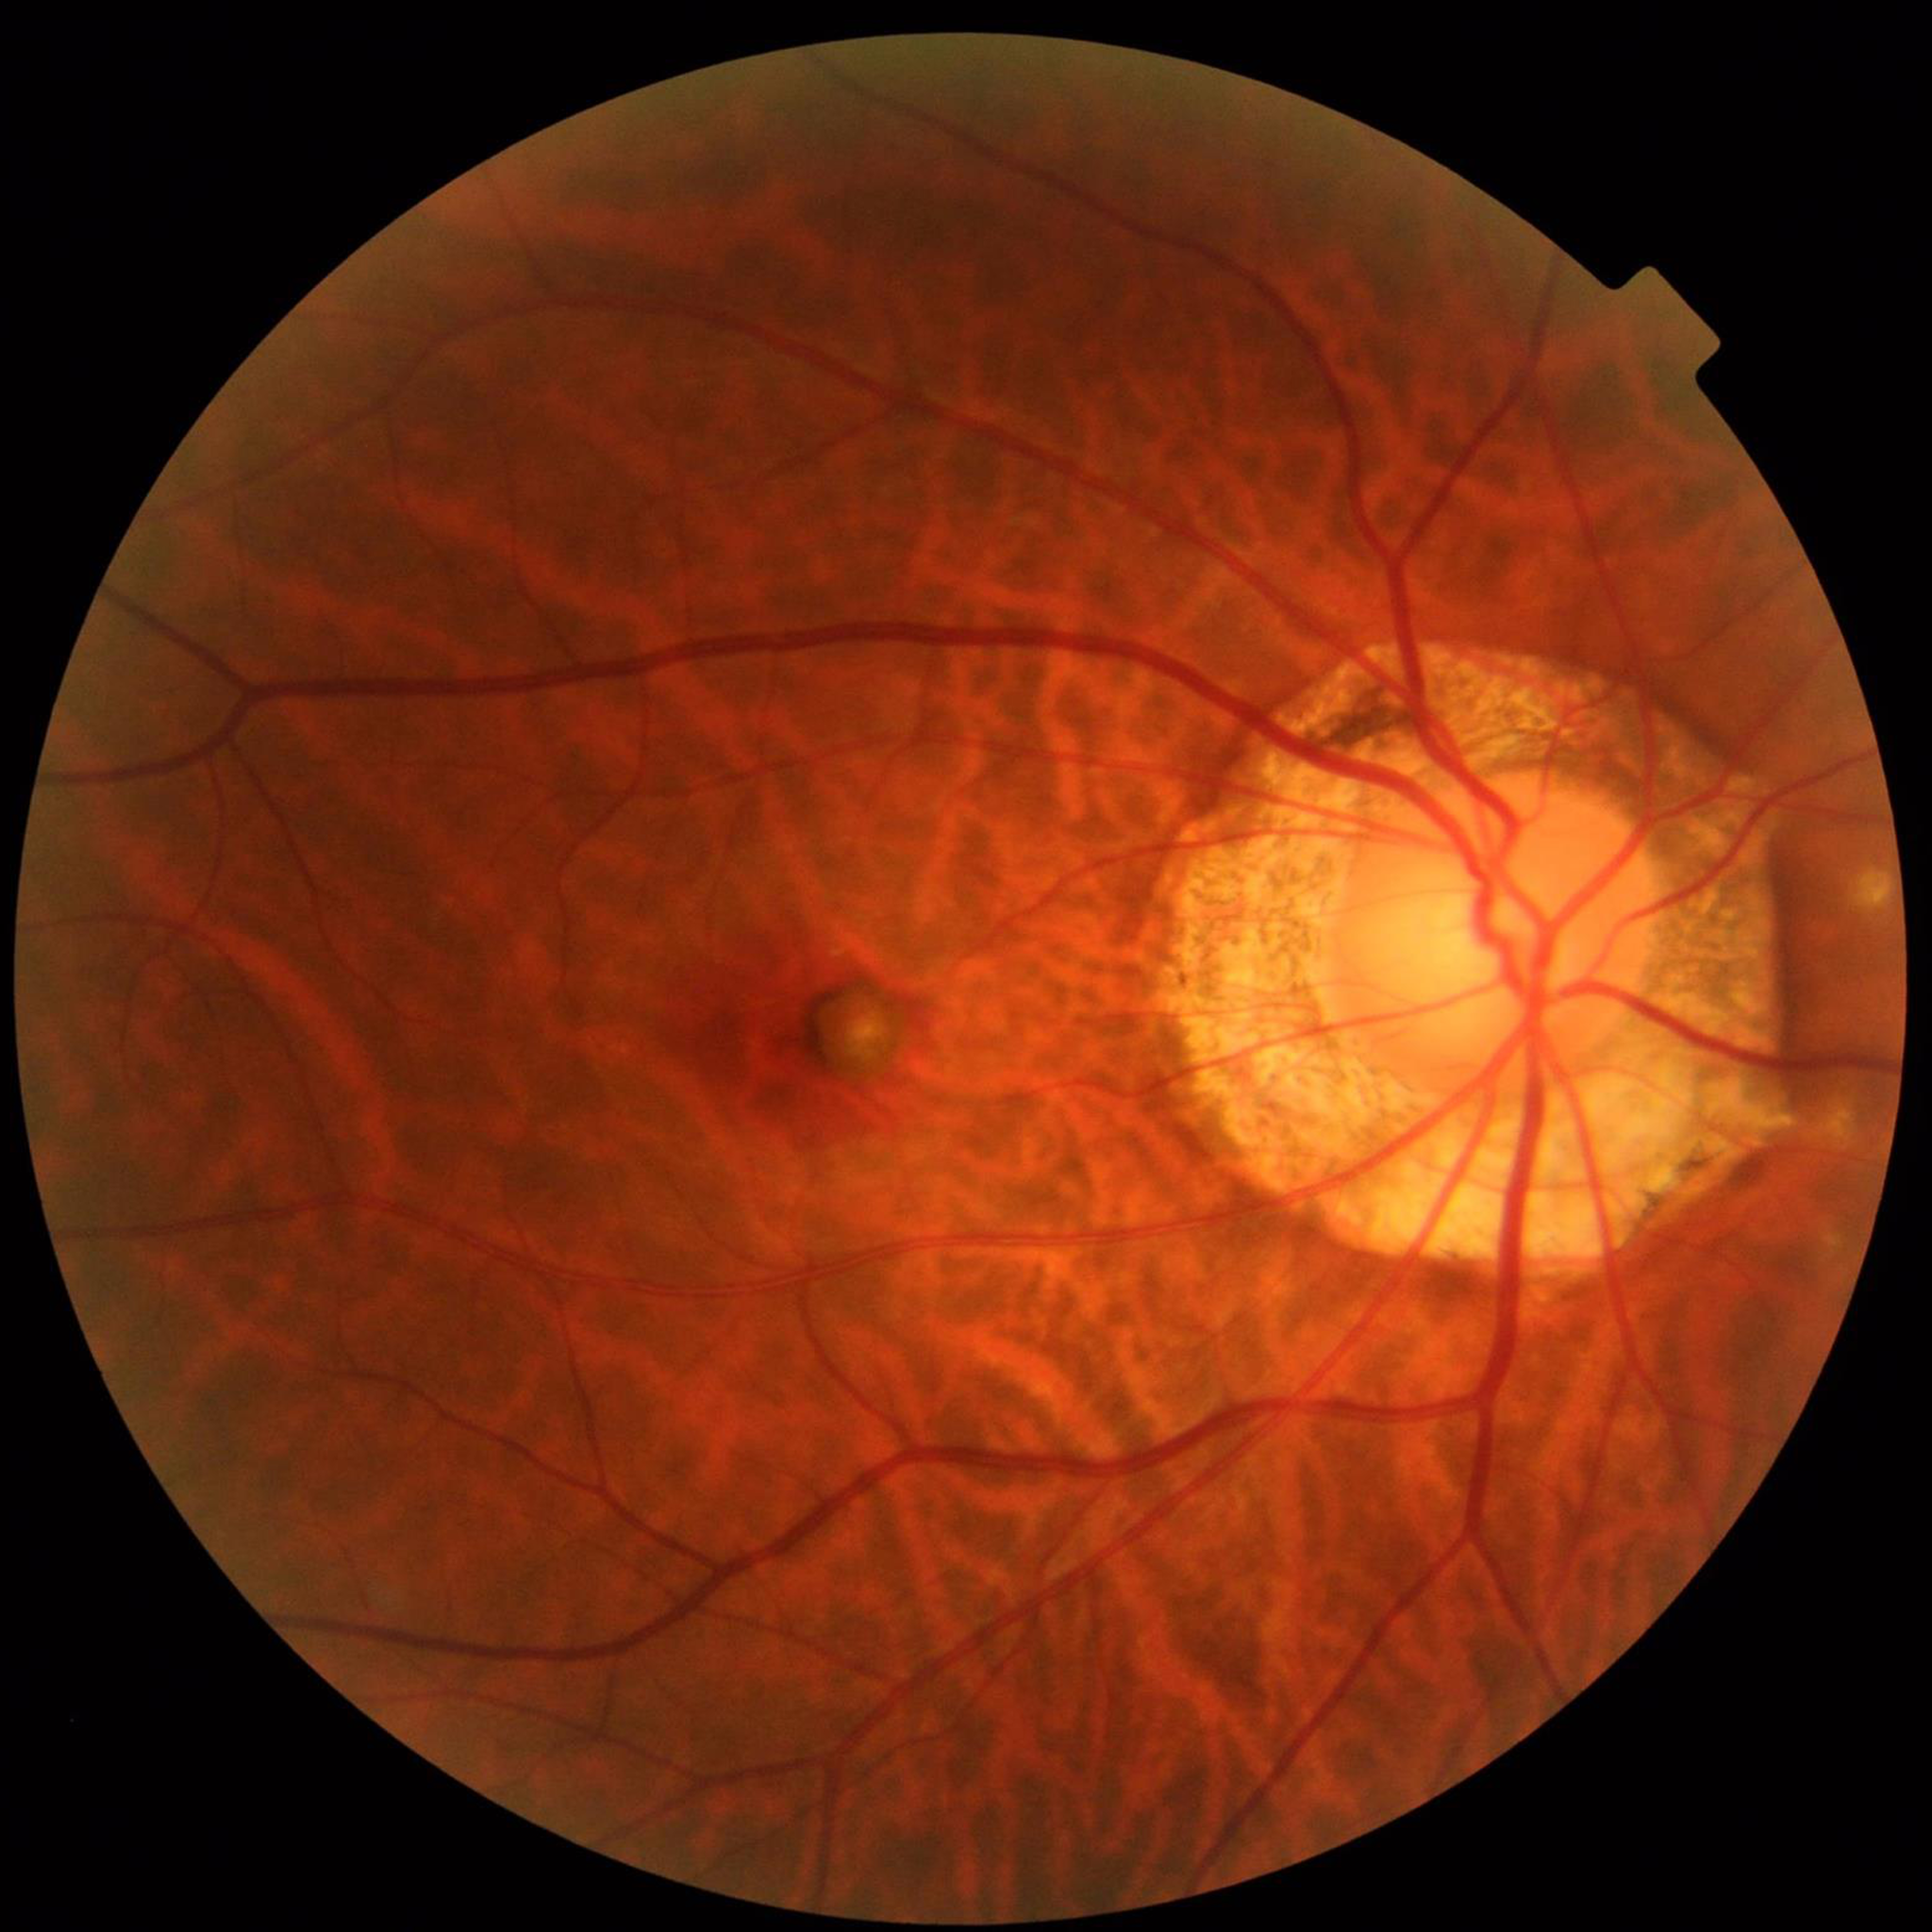
Fundus image of an eye with age-related macular degeneration (AMD).